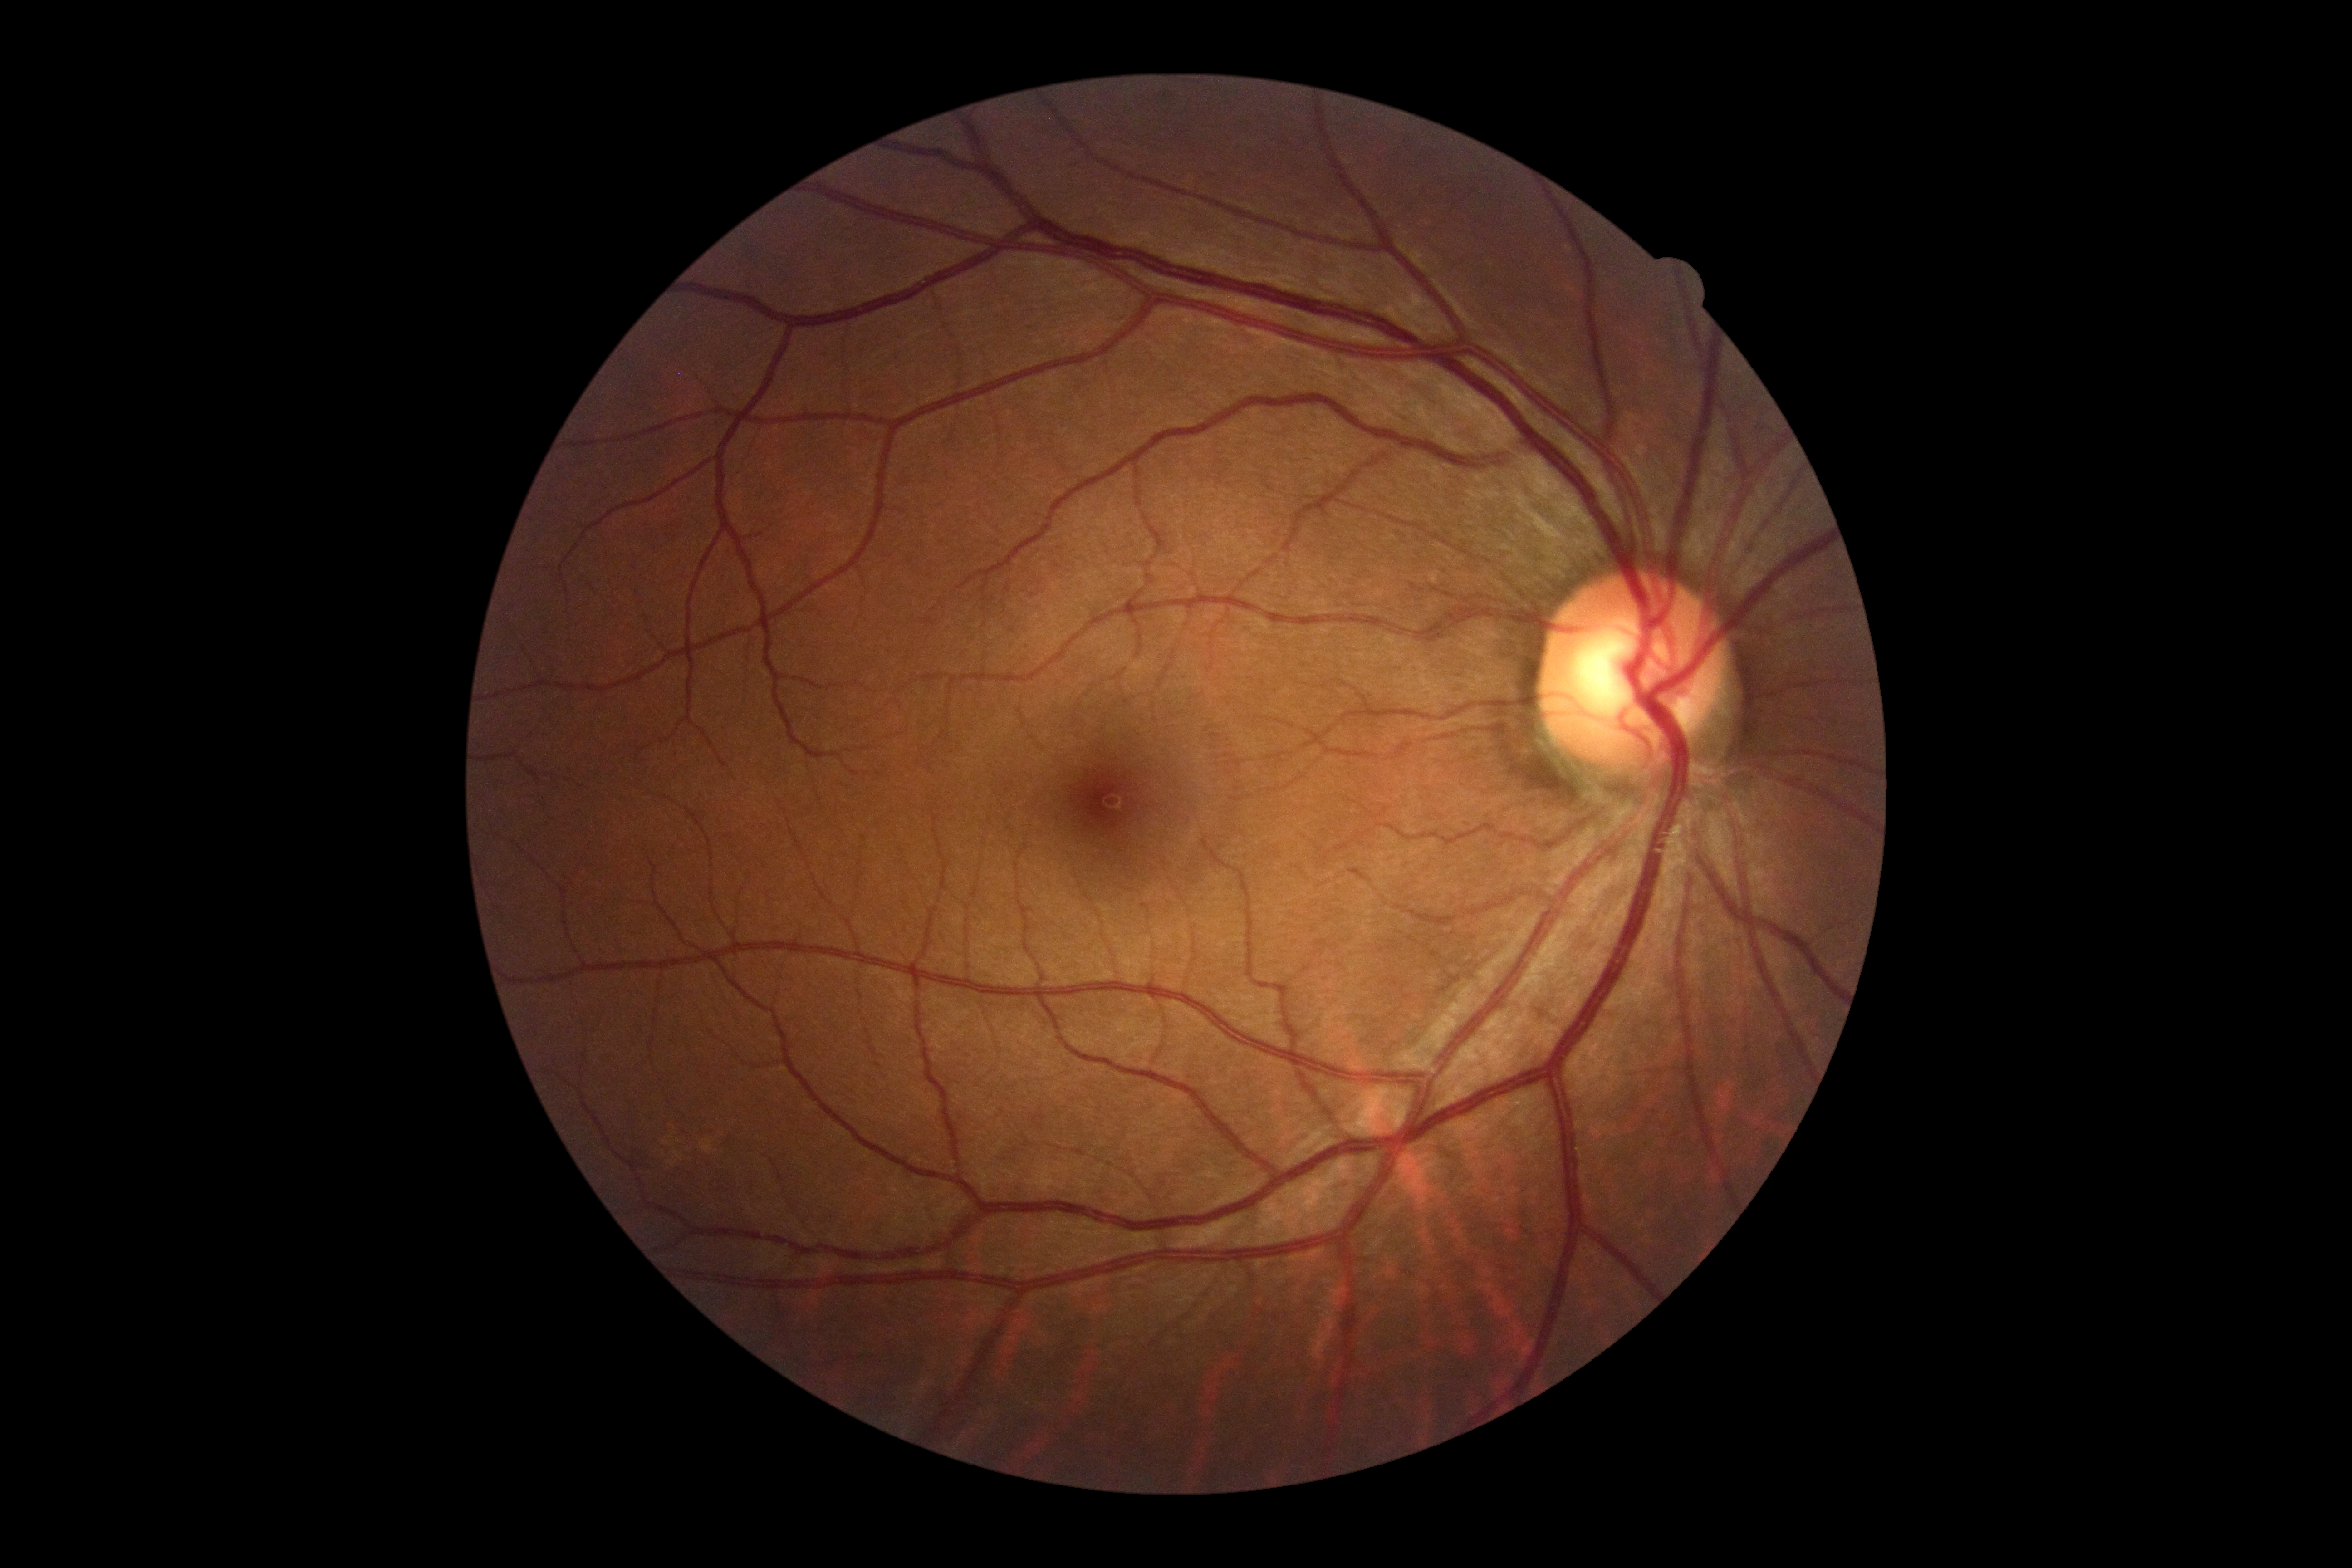

No signs of diabetic retinopathy.
Diabetic retinopathy (DR) is grade 0 (no apparent retinopathy).